848x848px; 45-degree field of view — 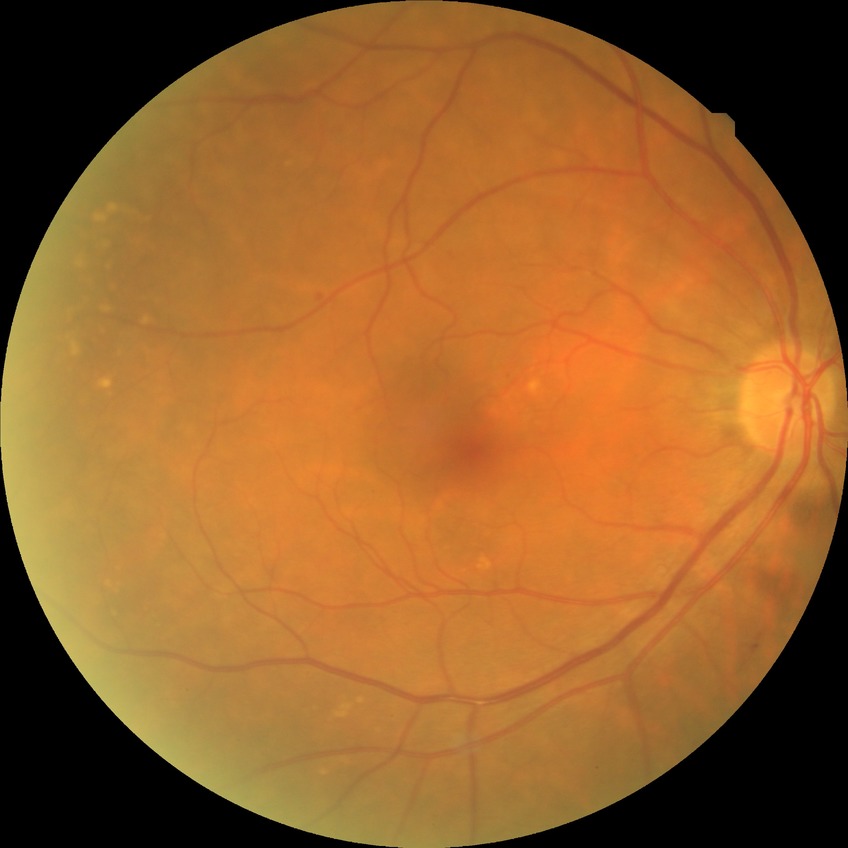
Modified Davis grading is simple diabetic retinopathy.